1932 x 1932 pixels. Captured after pupil dilation:
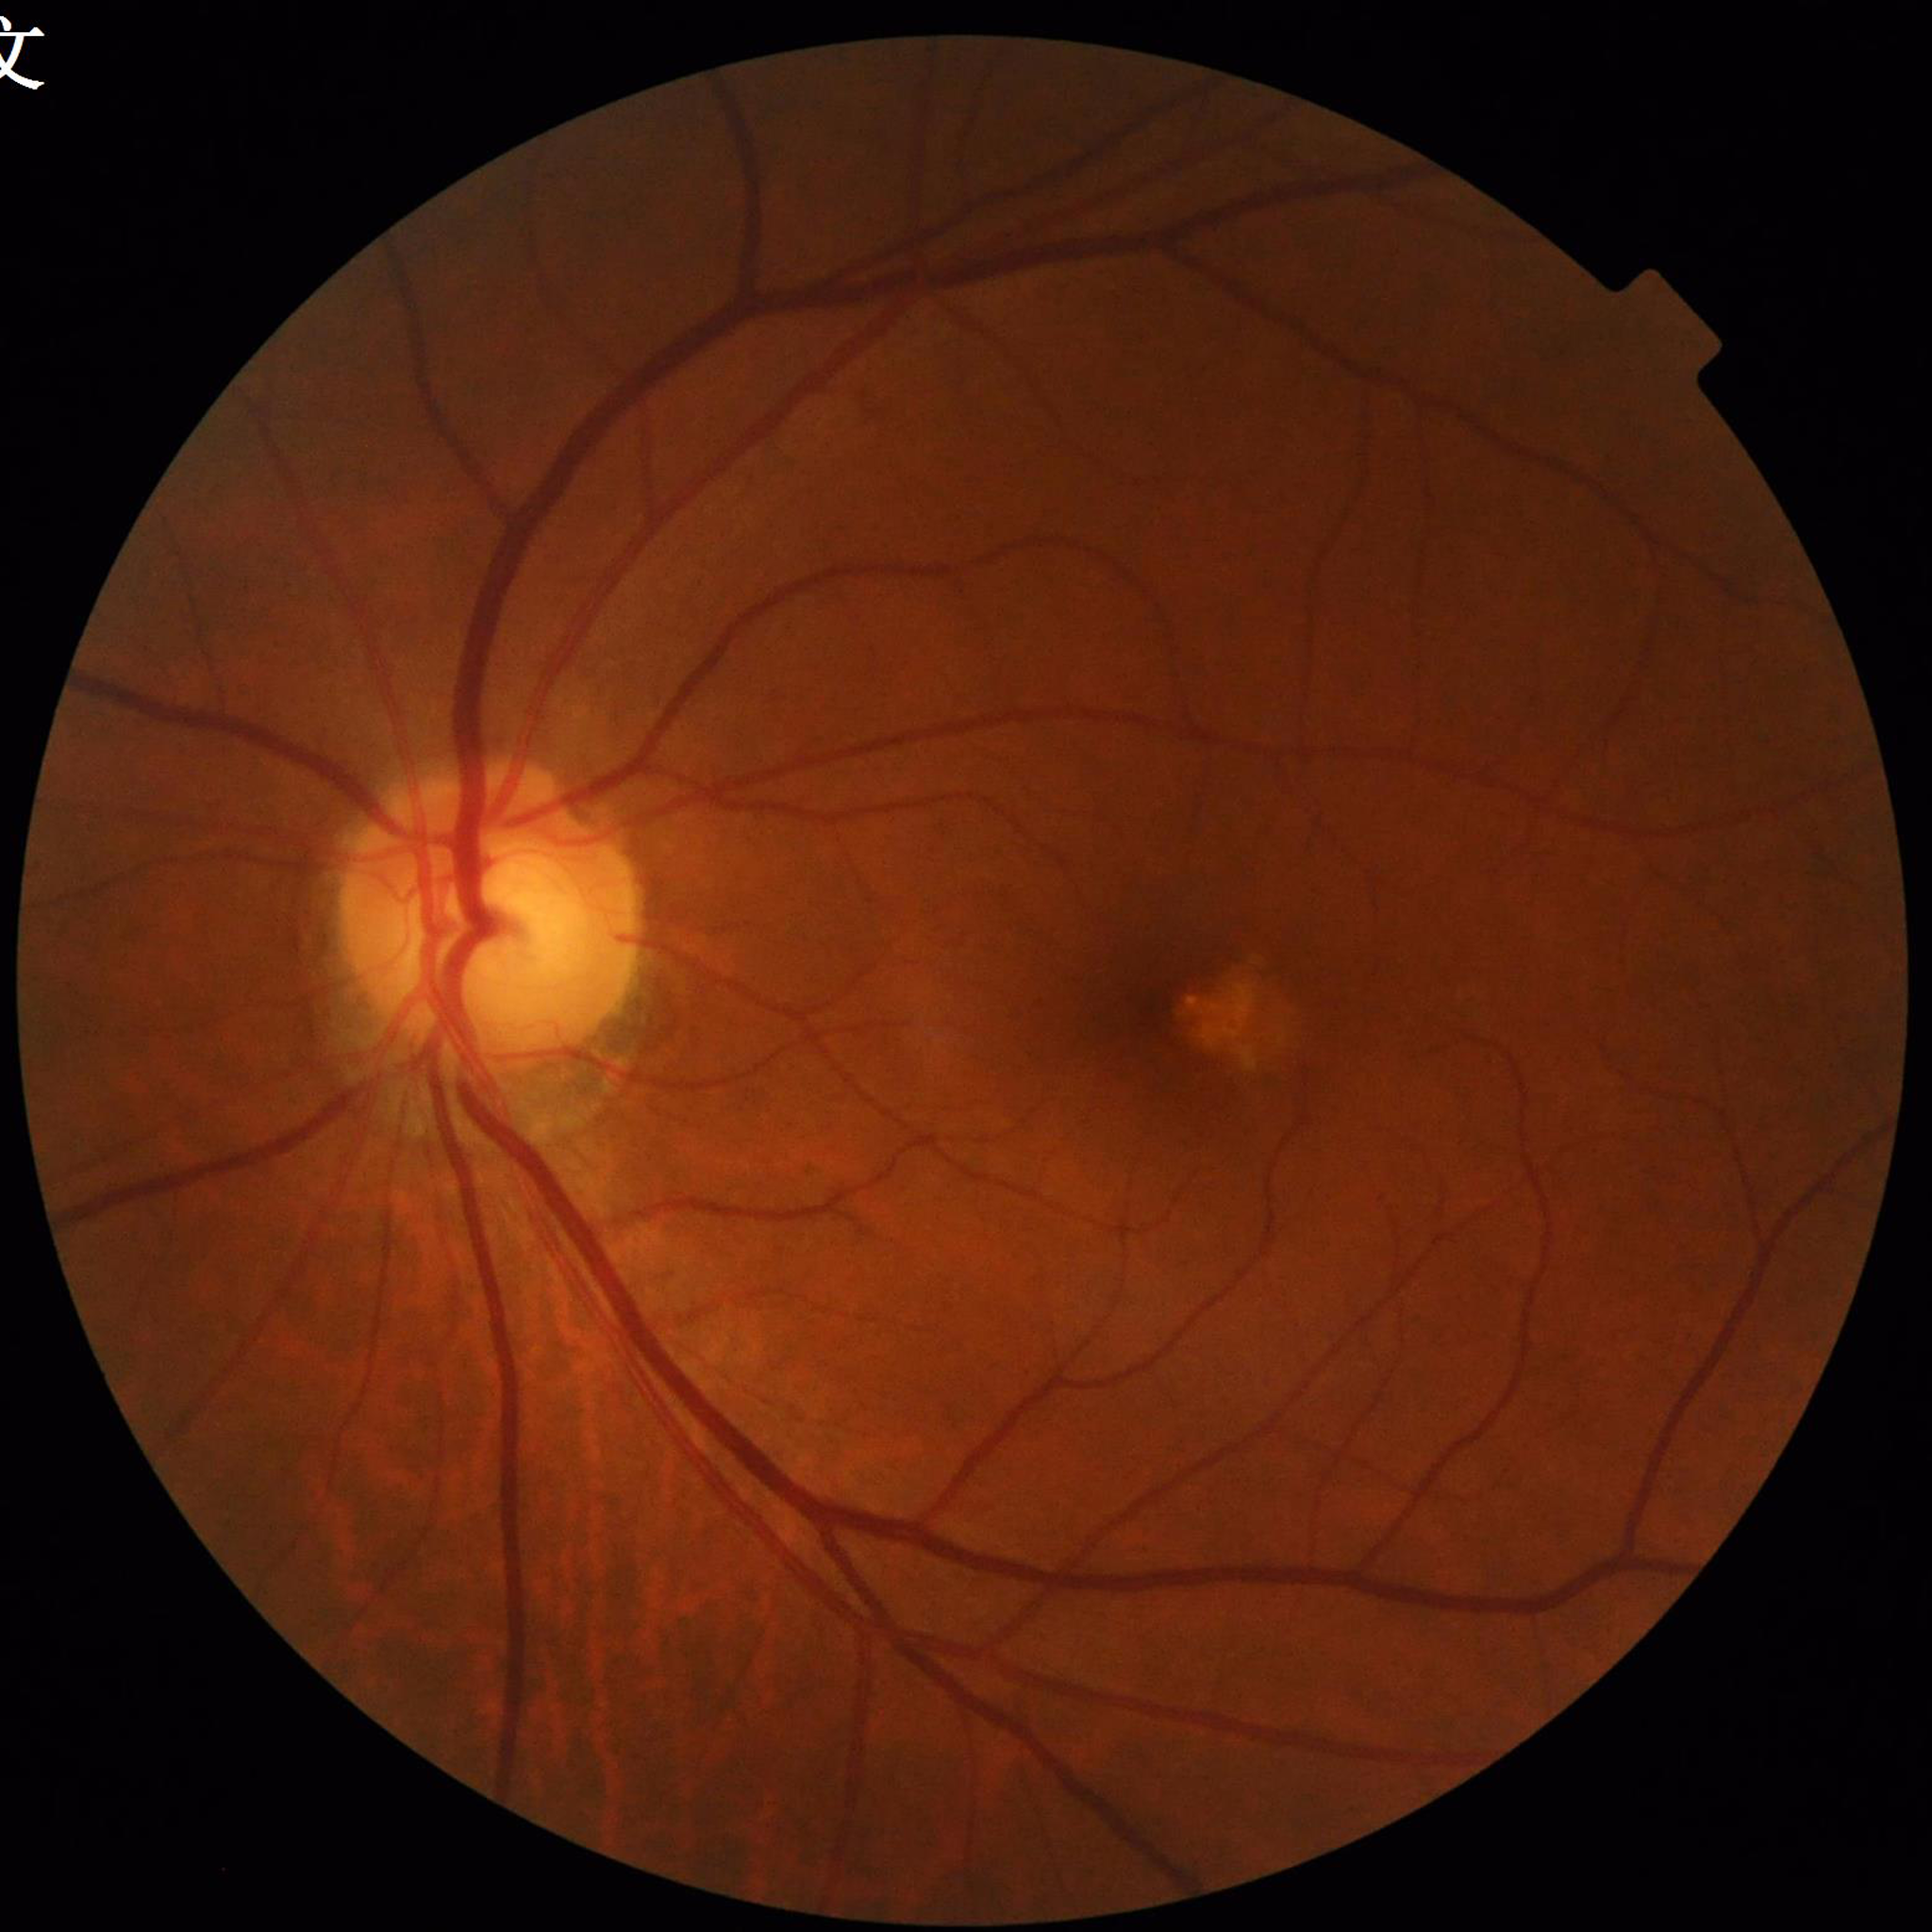

Disease class: age-related macular degeneration.